Dilated-pupil acquisition; image size 2228x1652:
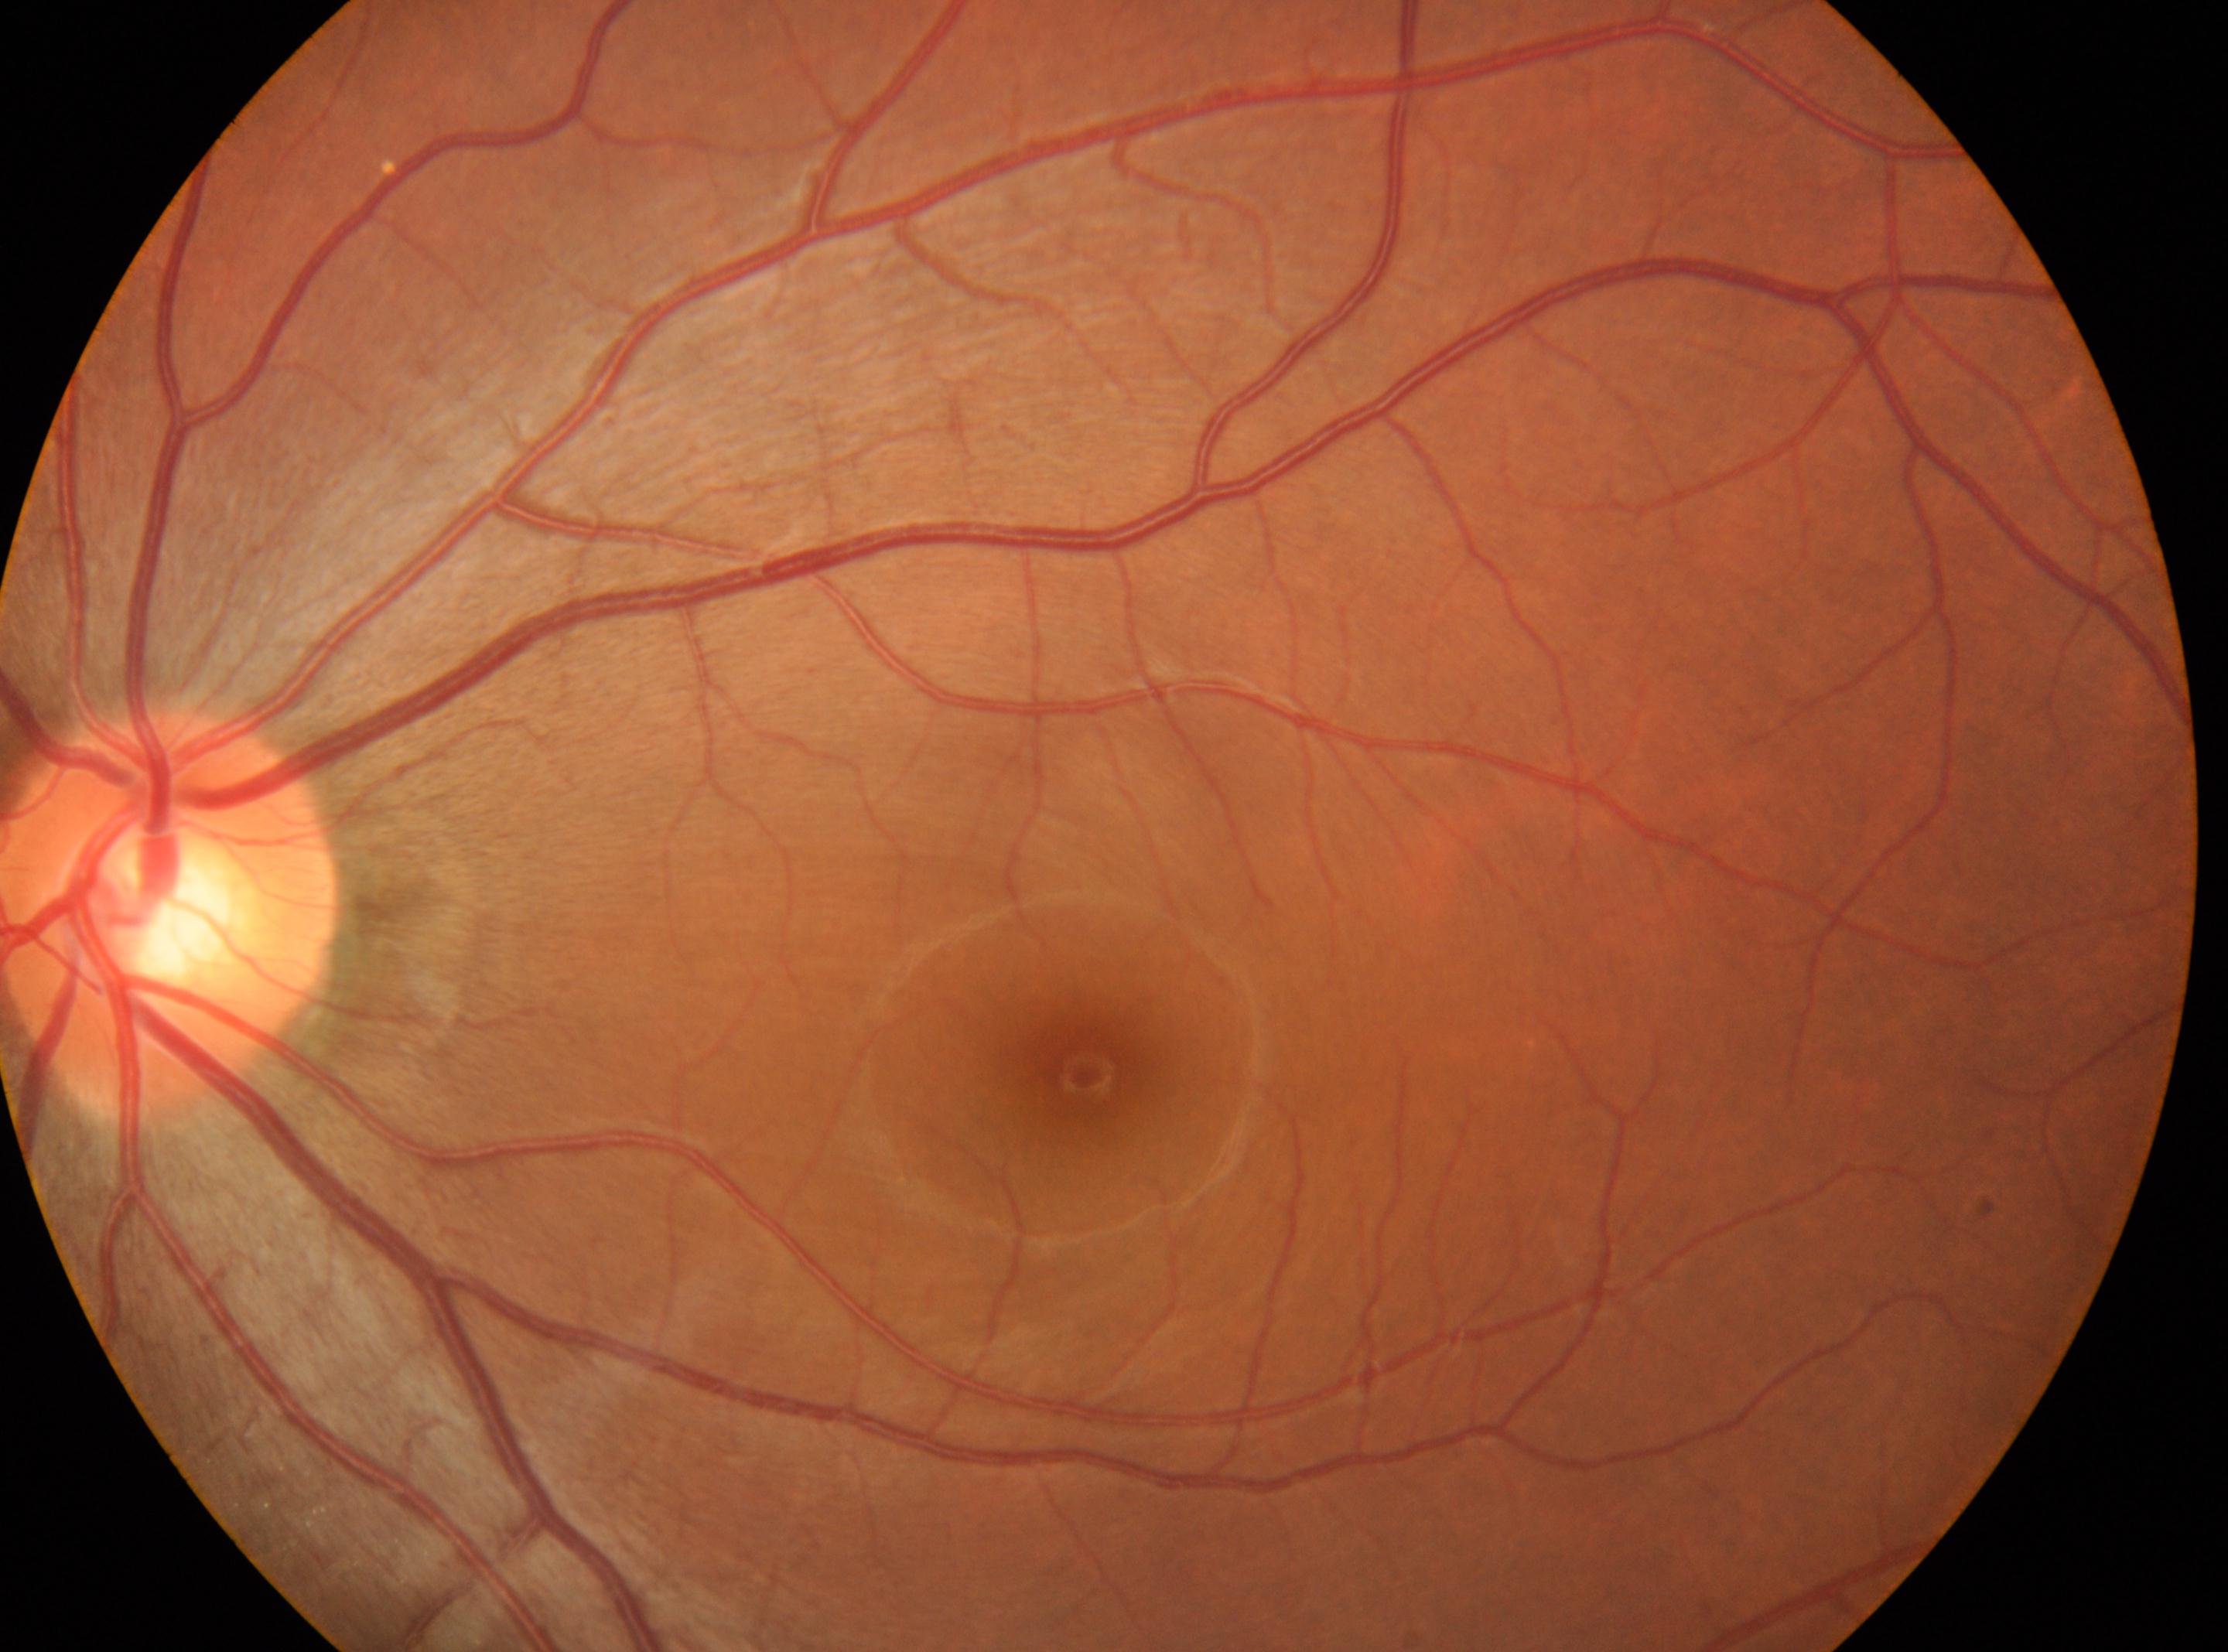 This is the left eye. Optic disc located at 170px, 915px. Fovea: 1083px, 1075px. Retinopathy is grade 0 (no apparent retinopathy).